No pharmacologic dilation · NIDEK AFC-230 fundus camera — 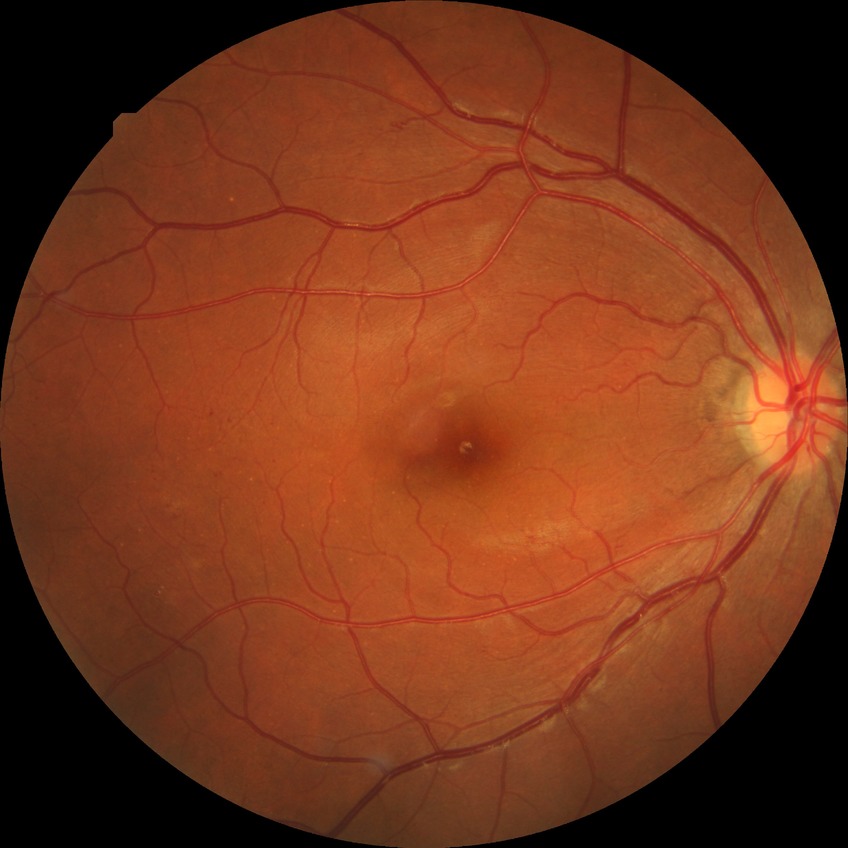

diabetic retinopathy (DR) = SDR (simple diabetic retinopathy)